Captured on a Nidek AFC-330 fundus camera
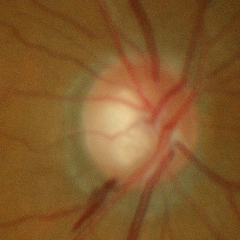

Optic disc appearance consistent with early glaucomatous optic neuropathy.